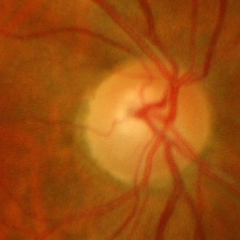 Q: Does this eye have glaucoma?
A: Yes — advanced-stage glaucoma.